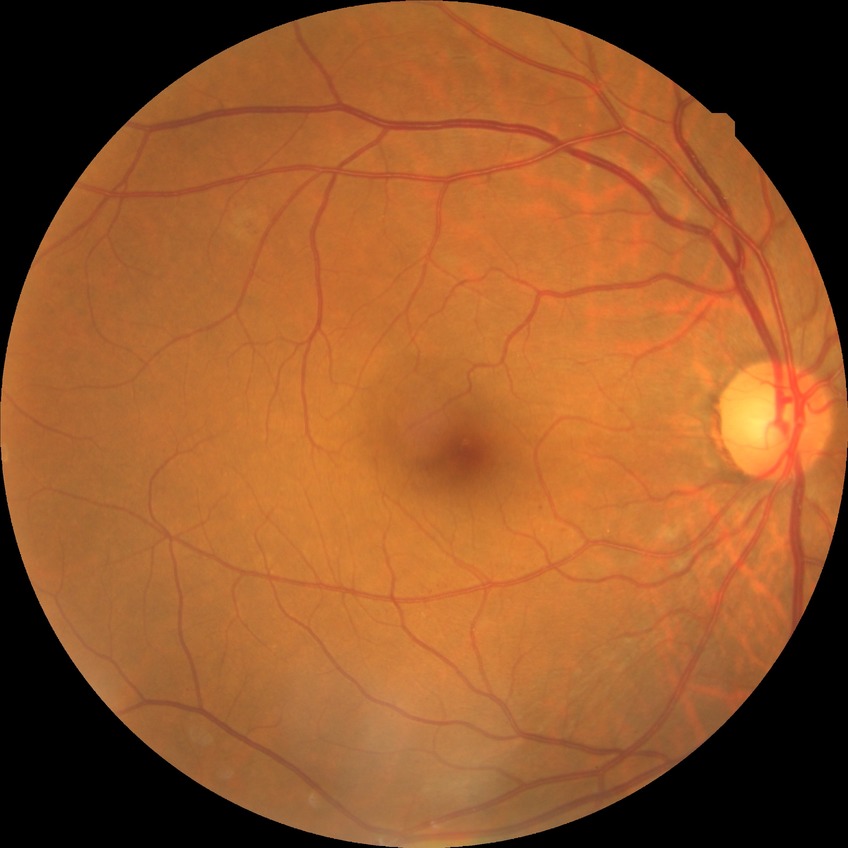

Diabetic retinopathy (DR): simple diabetic retinopathy (SDR).